45° field of view; color fundus image: 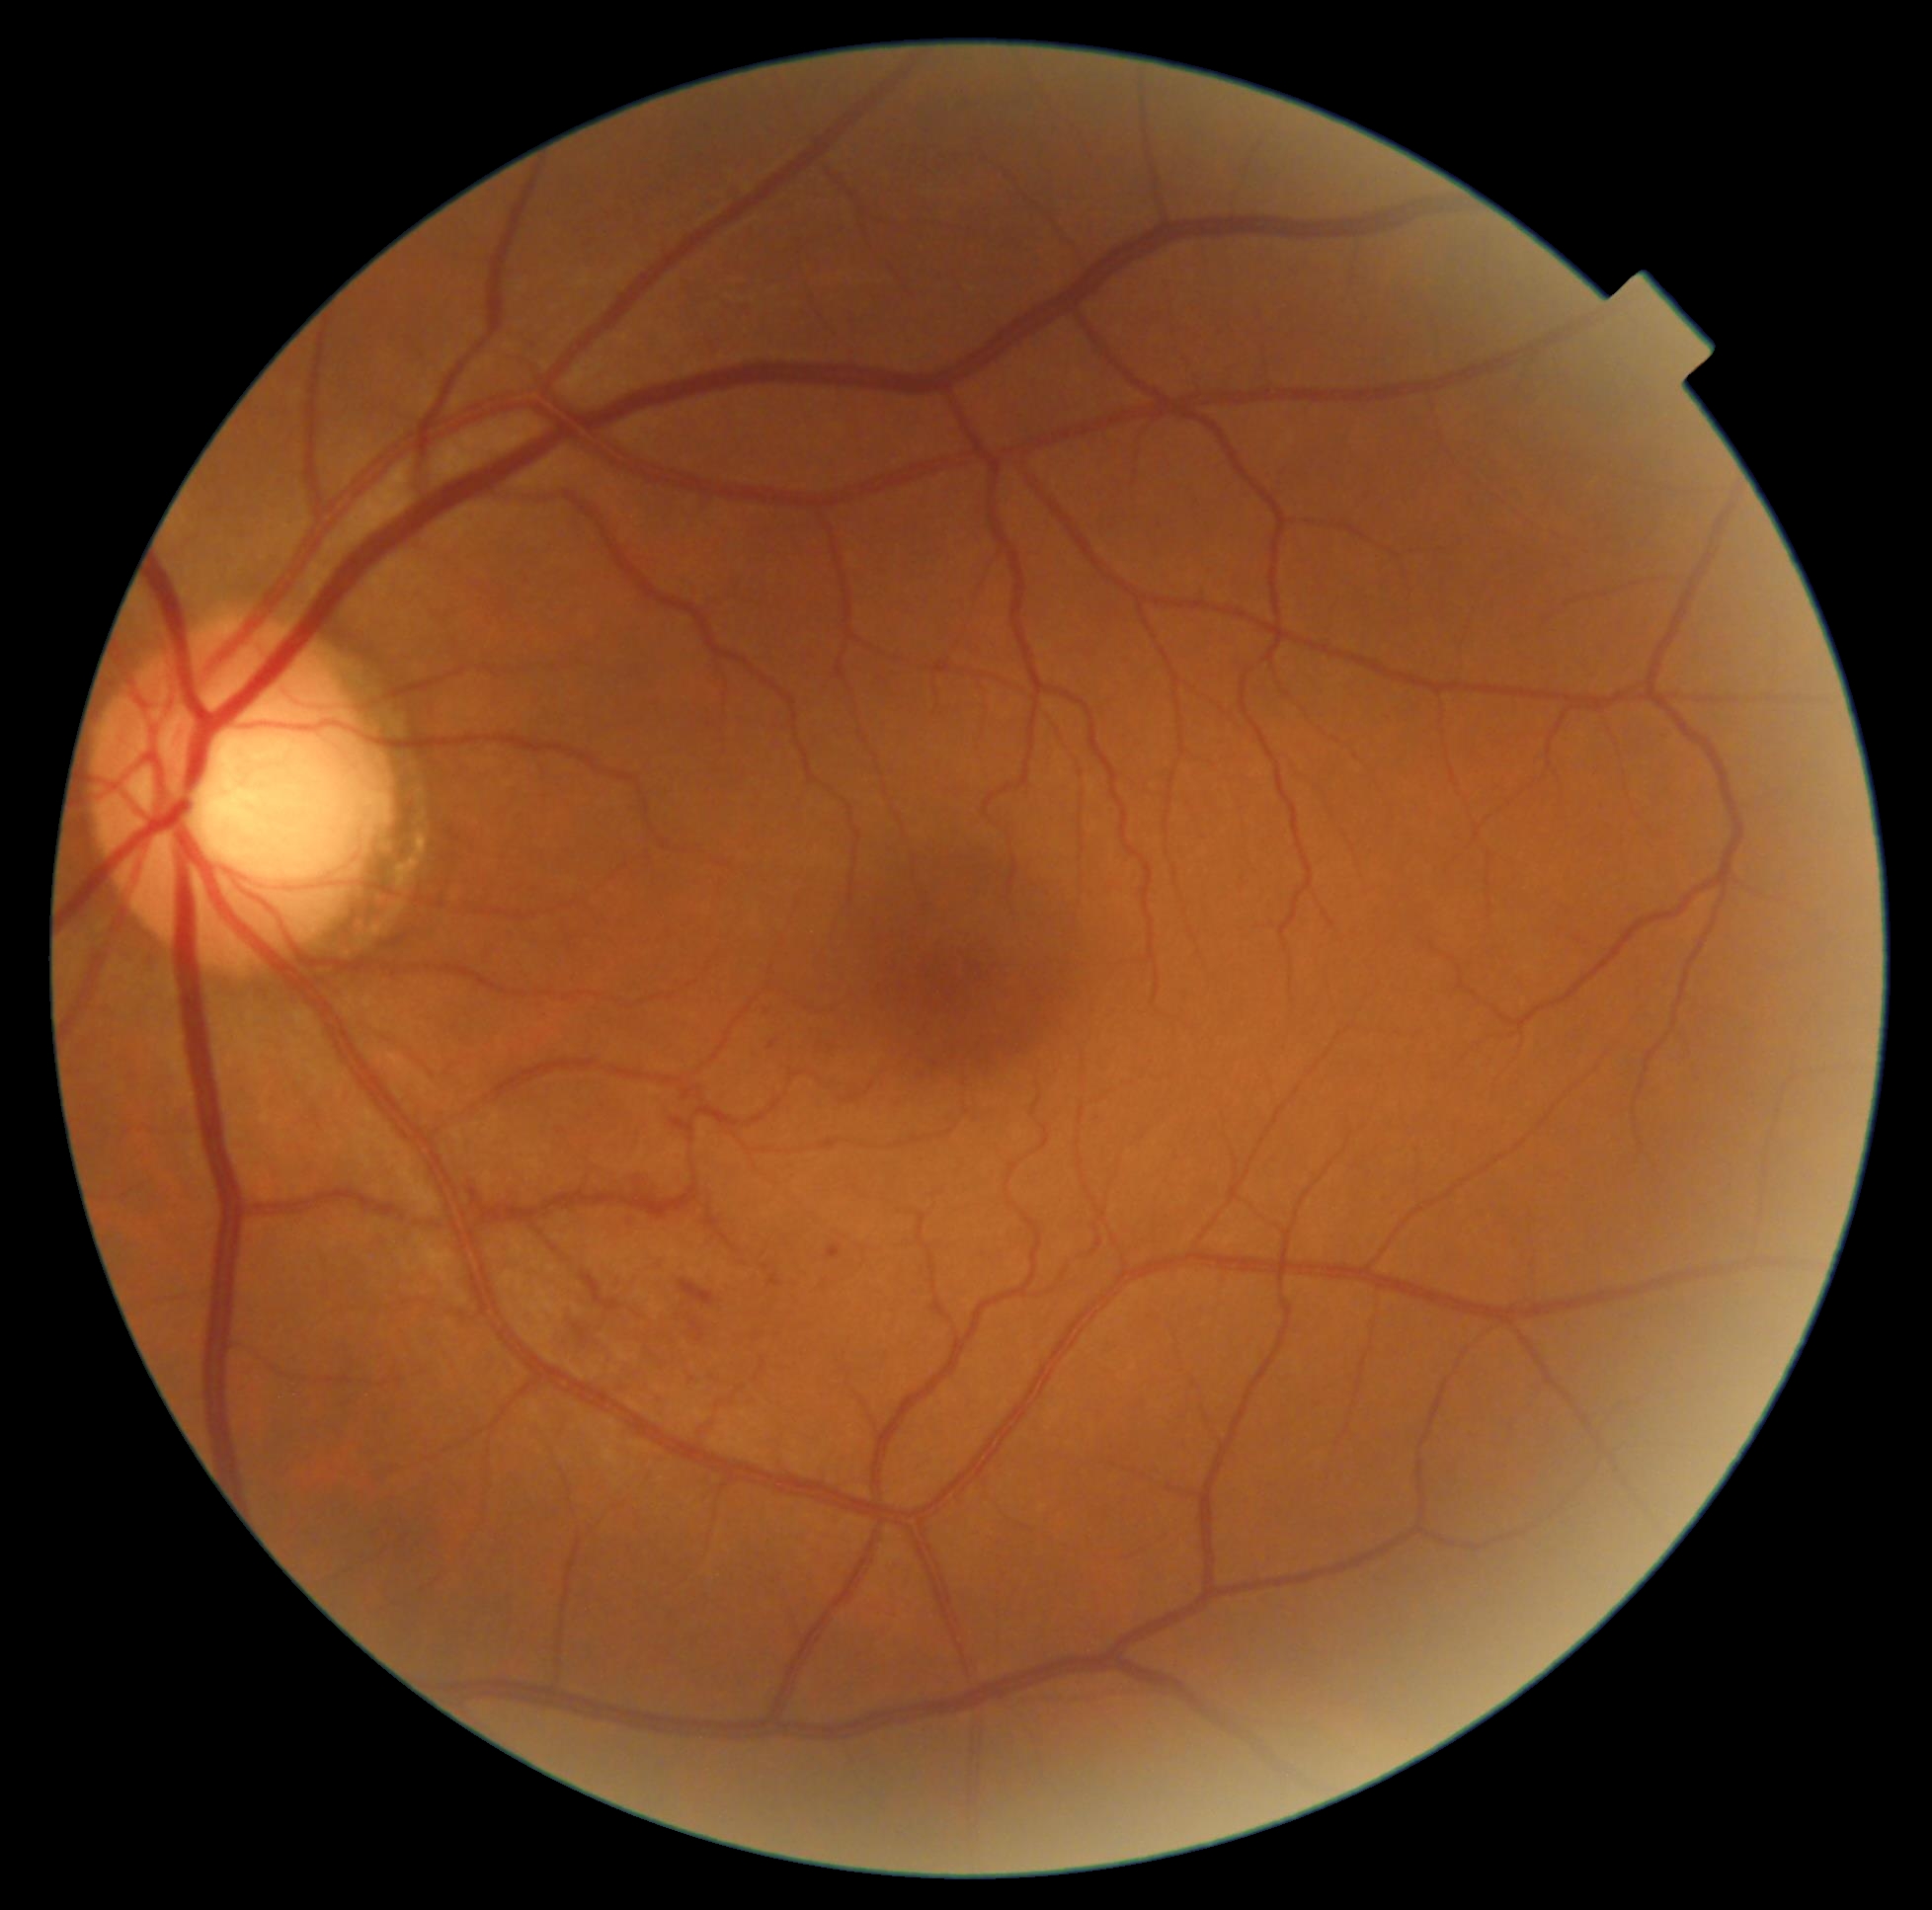 Diabetic retinopathy (DR): grade 2.